UWF retinal mosaic: 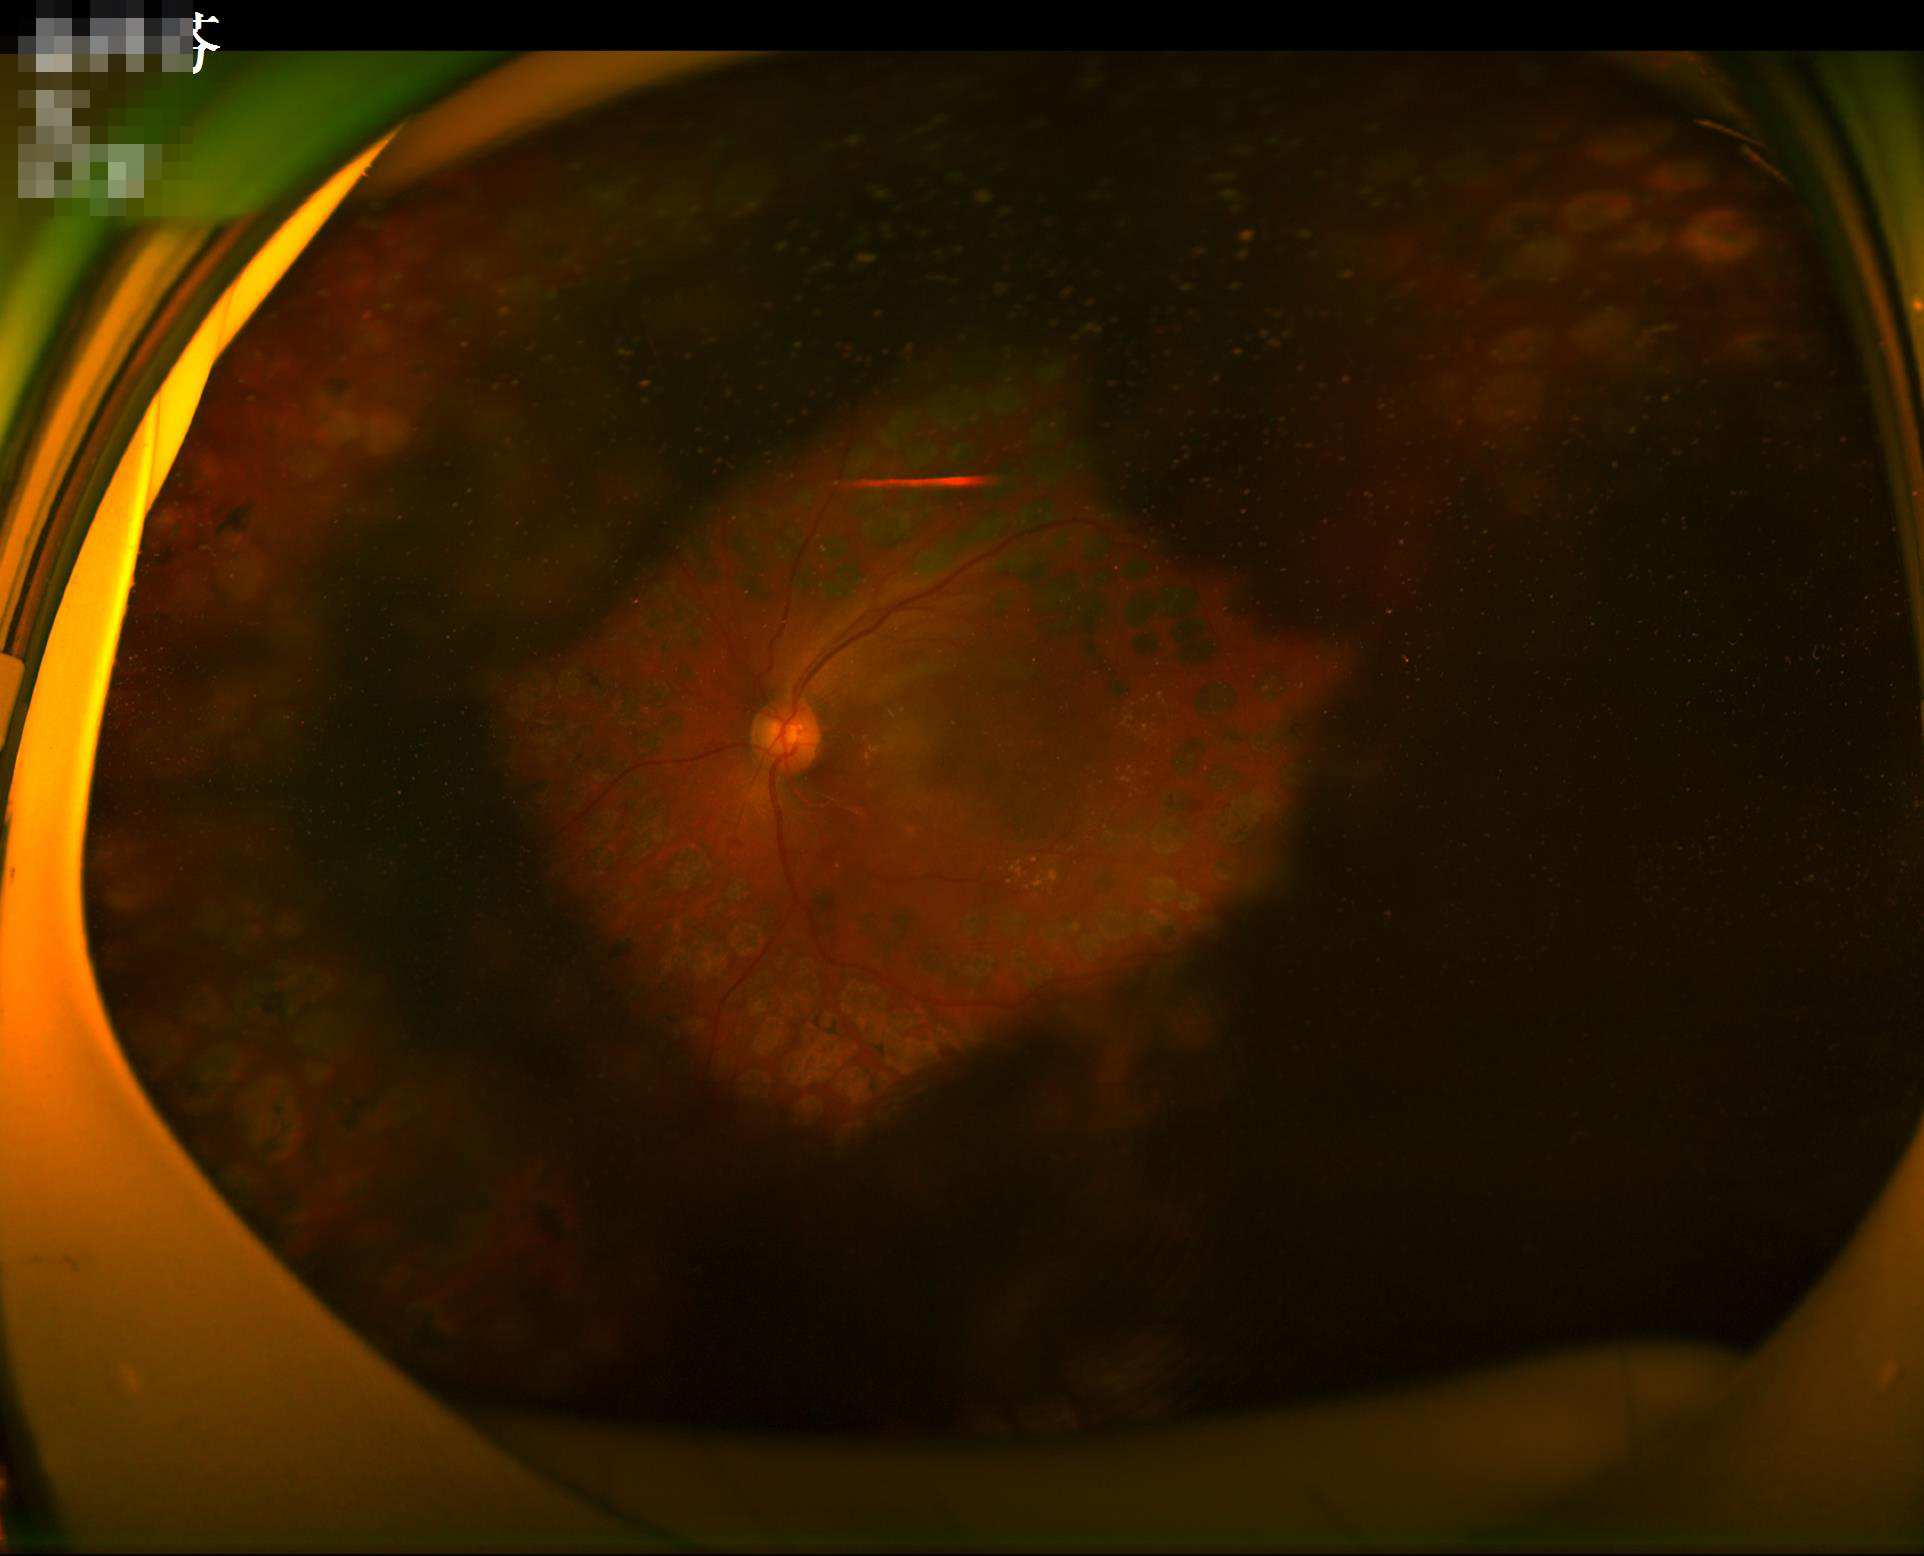 Poor illumination with uneven exposure. Out of focus; structures are indistinct. Image quality is suboptimal.